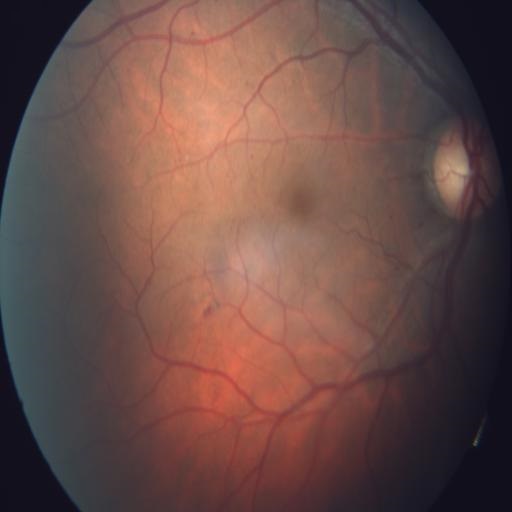
Showing TD (tilted disc).